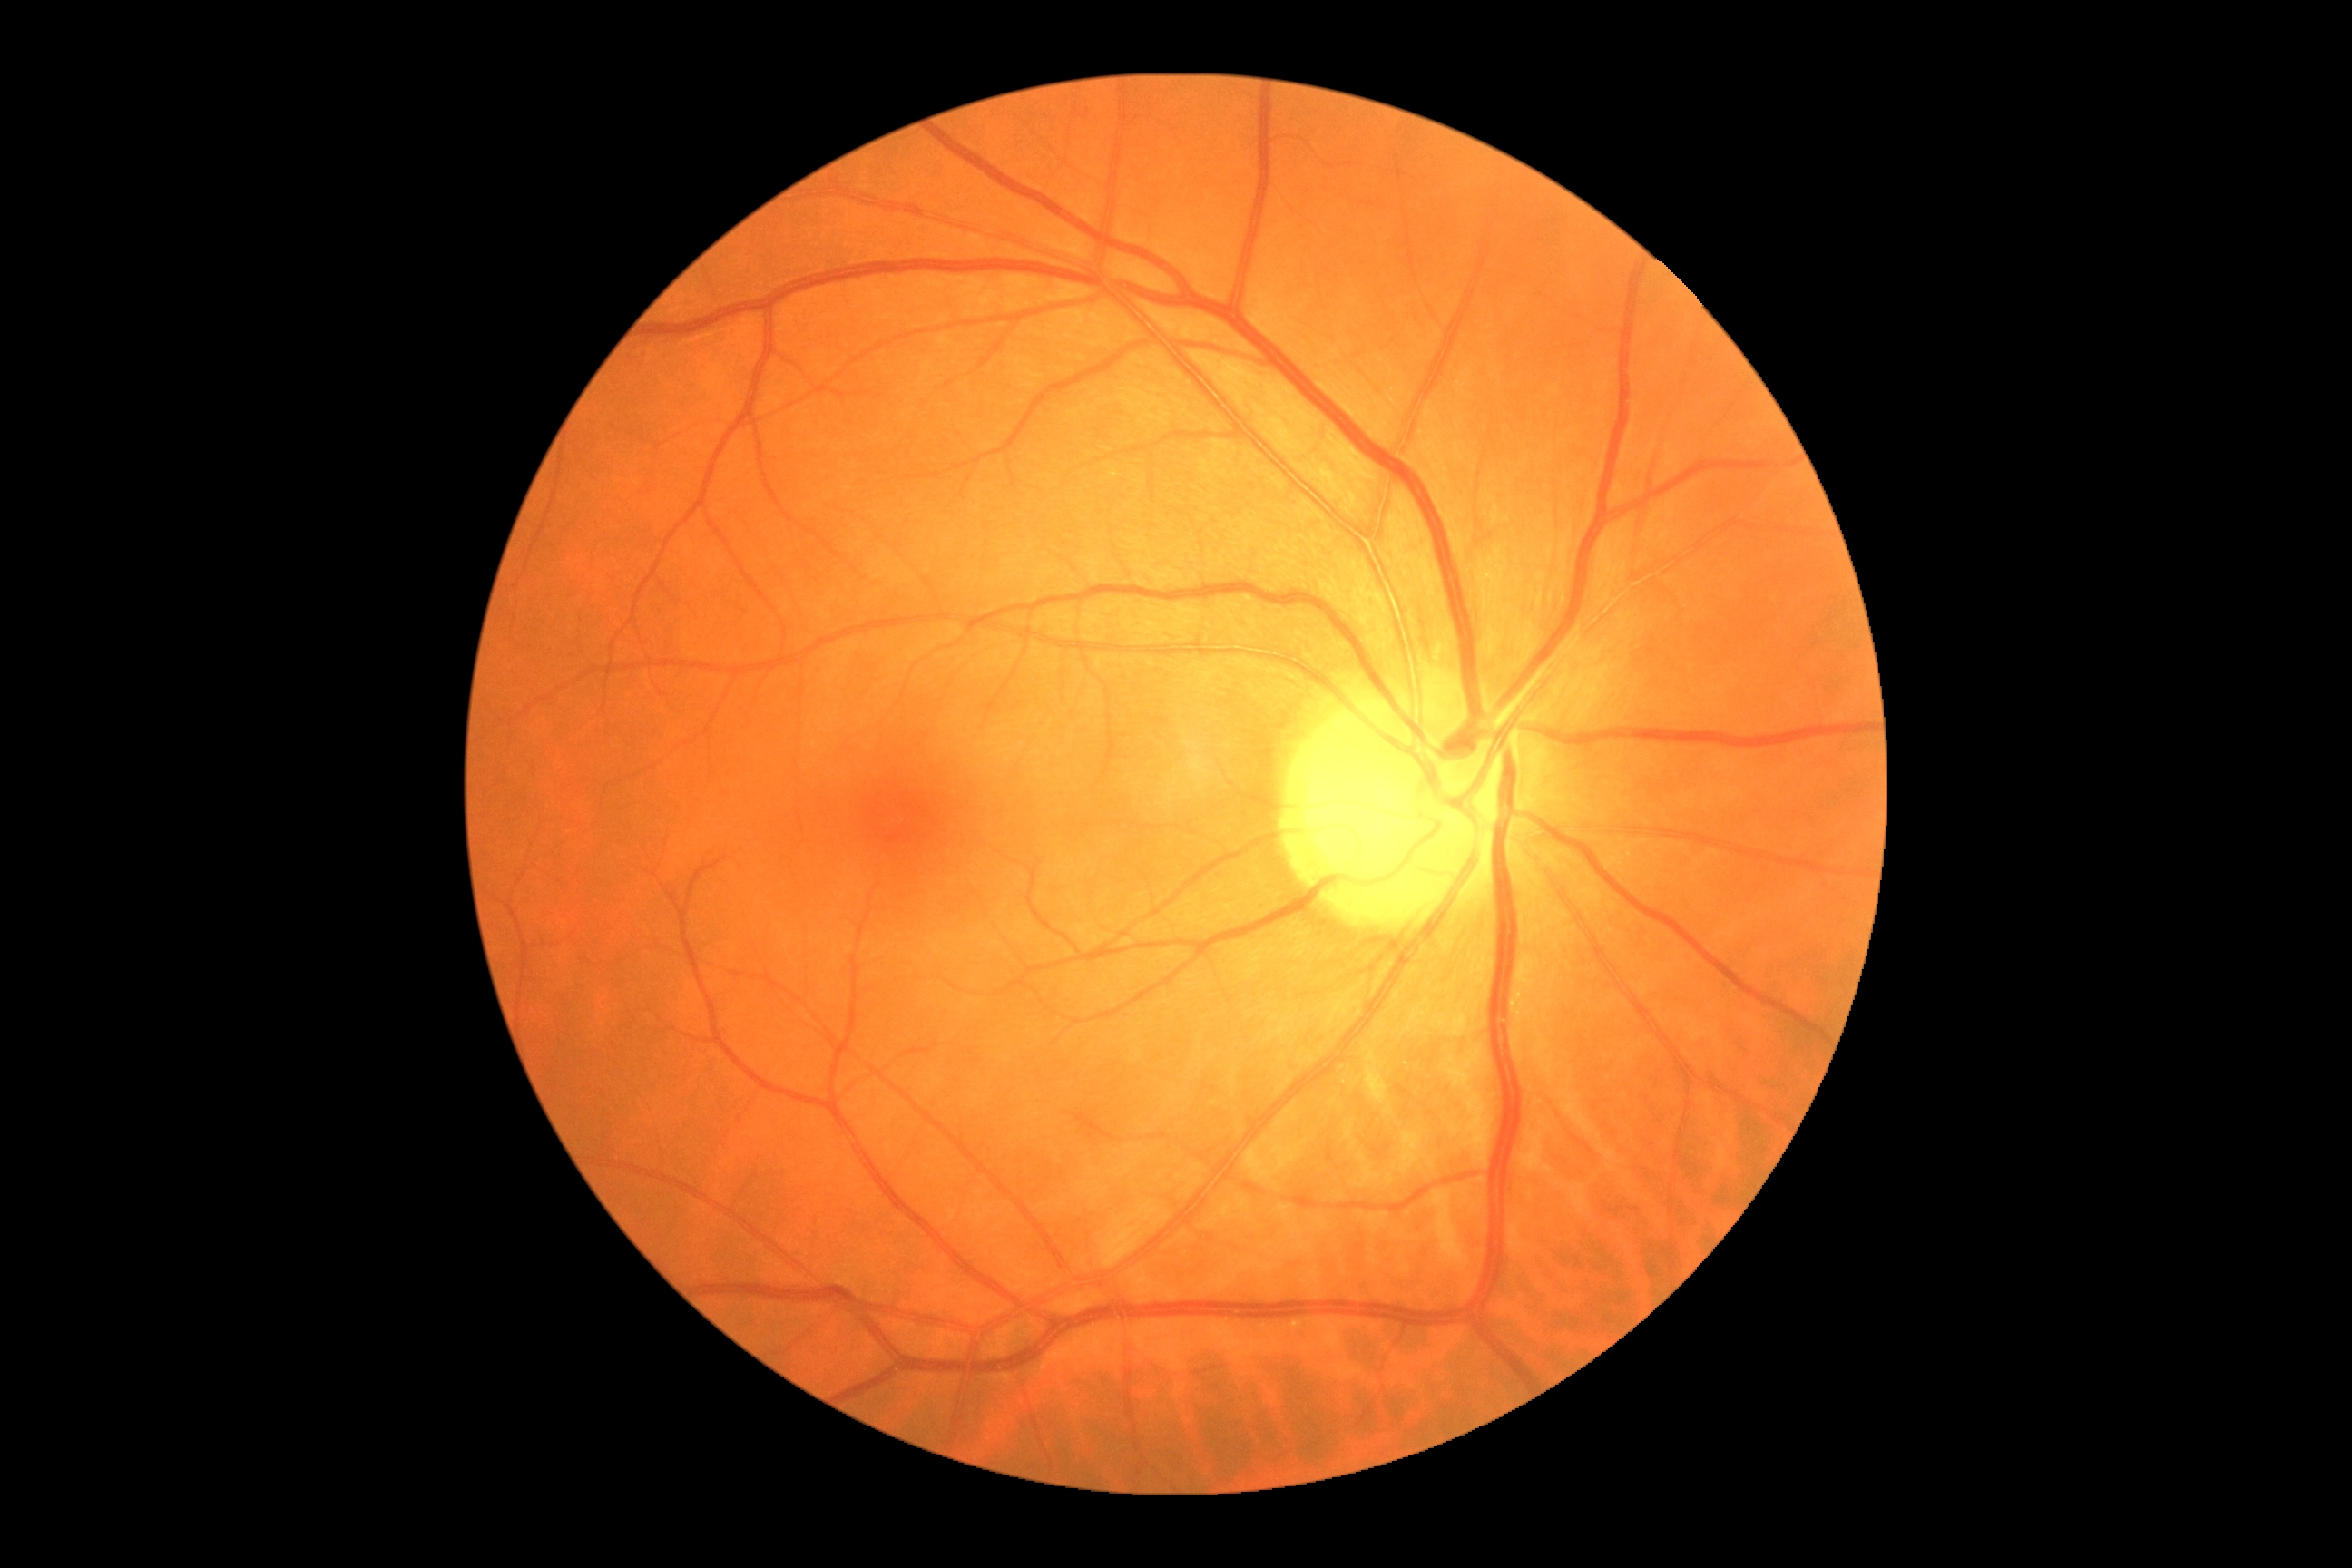

DR stage is no apparent diabetic retinopathy (grade 0).
No DR findings.